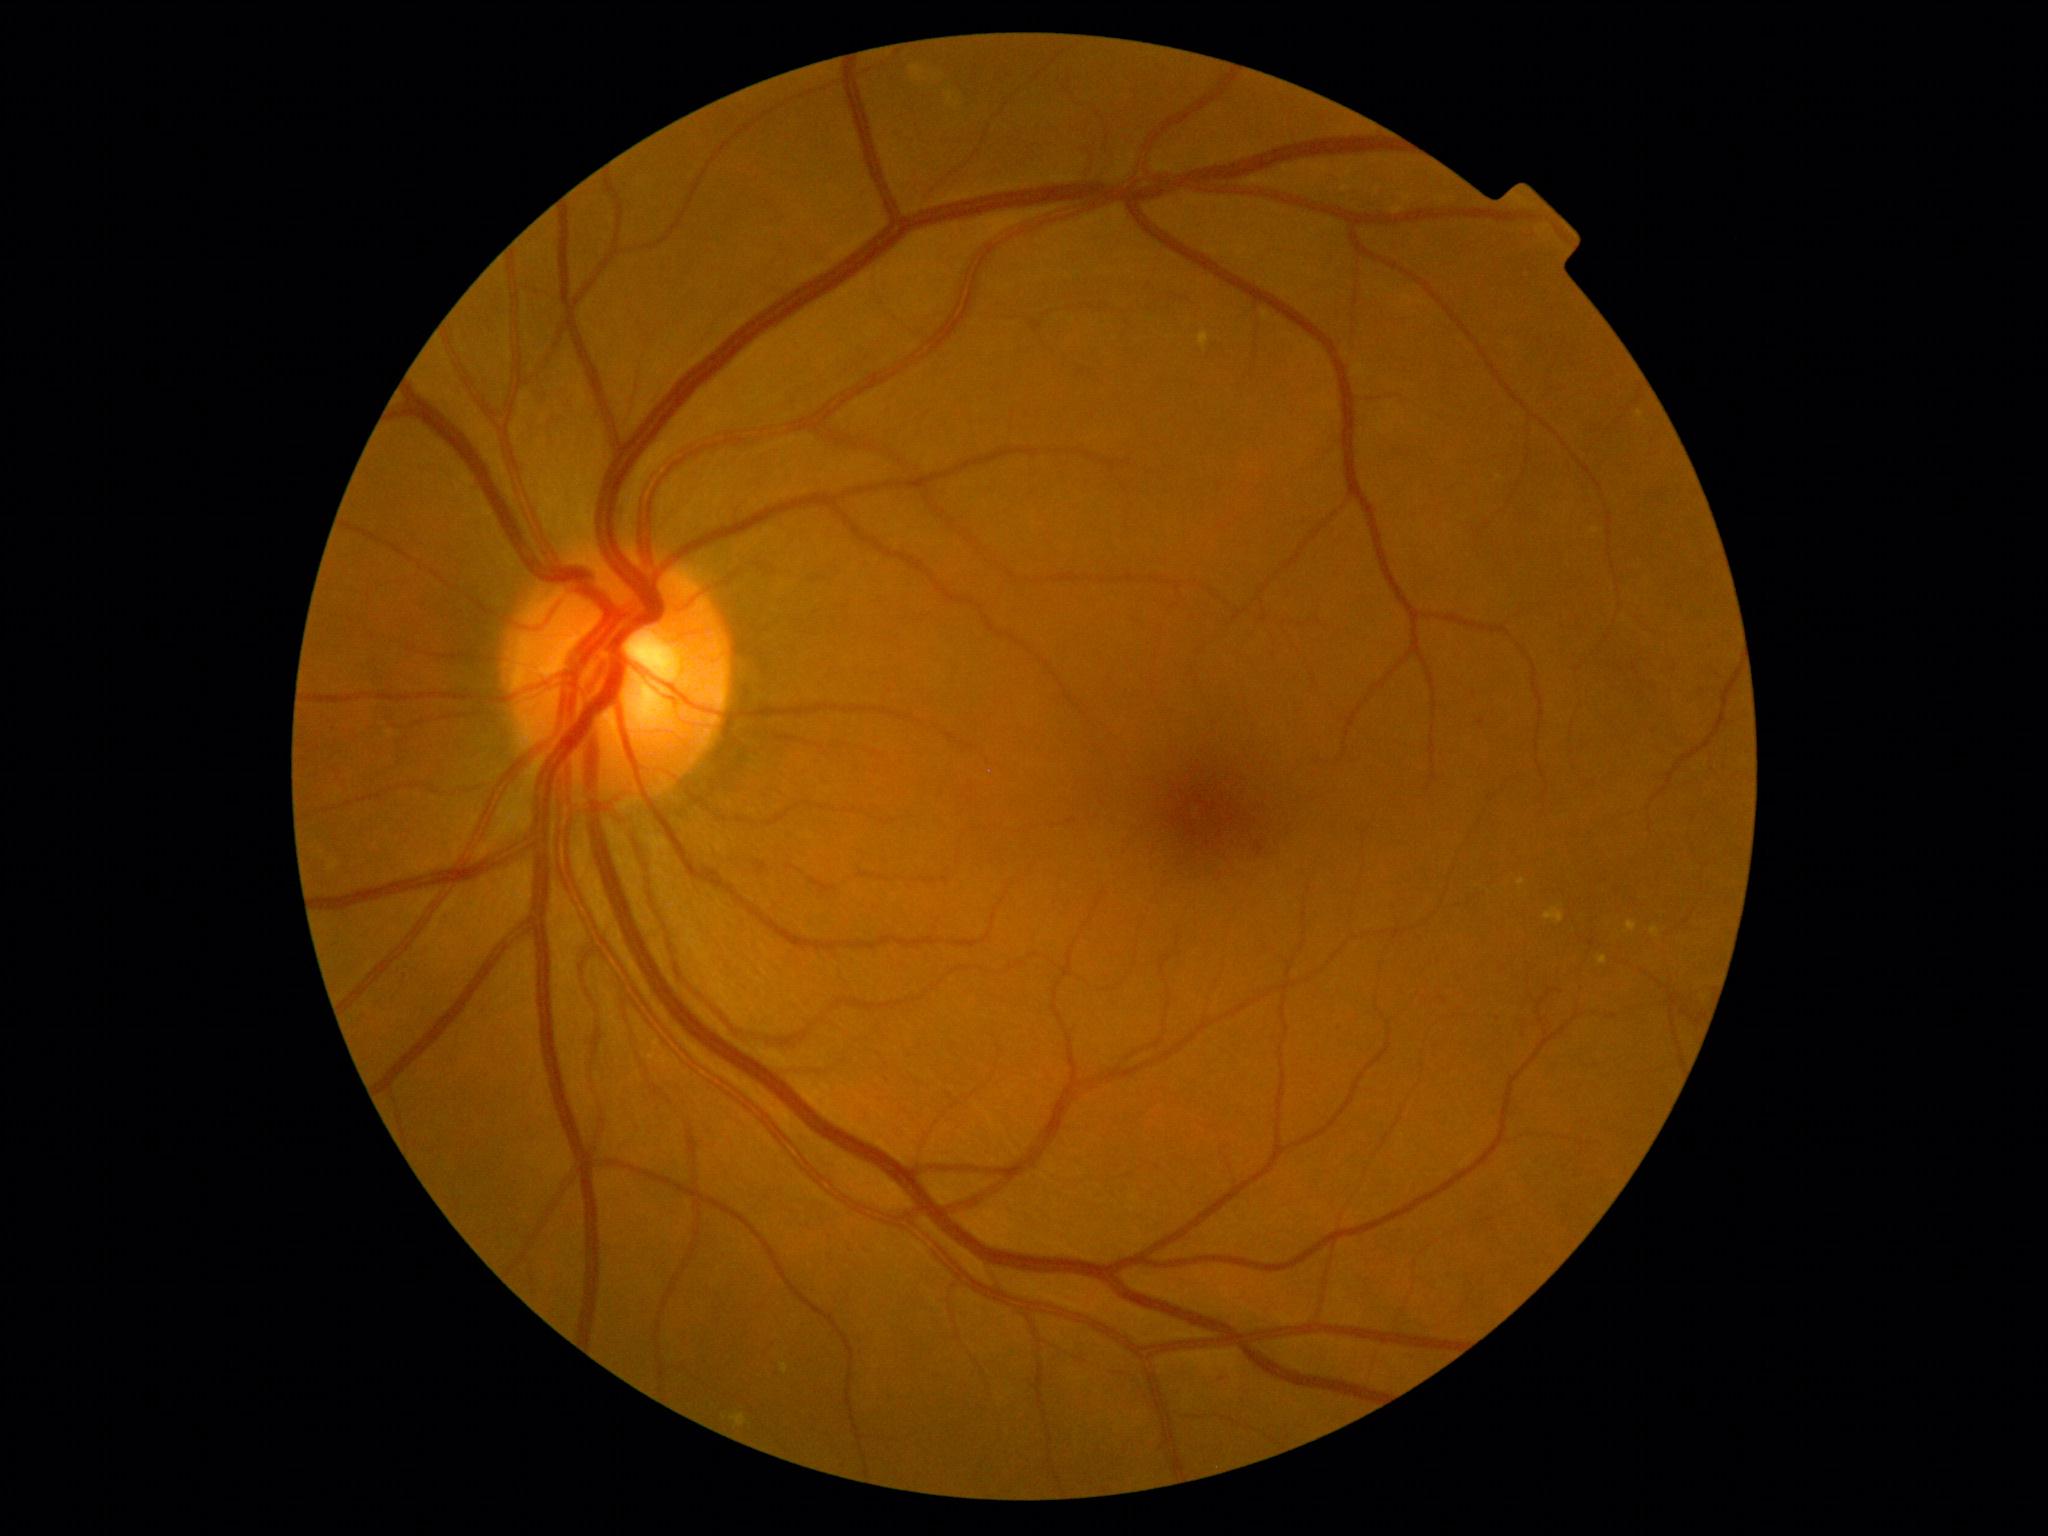 Diabetic retinopathy severity: grade 2. No hemorrhages identified. No soft exudates identified. Microaneurysms at [1214, 1373, 1228, 1382] | [1255, 842, 1265, 856]. Small microaneurysms near [1482, 723] | [1474, 694]. Hard exudates at [1518, 879, 1526, 888] | [782, 1364, 789, 1374] | [1199, 333, 1209, 352] | [1637, 410, 1644, 419] | [1545, 908, 1565, 924] | [1625, 921, 1638, 934] | [731, 1414, 747, 1429] | [1598, 957, 1608, 966] | [1651, 927, 1661, 938]. Small hard exudates near [1595, 531].